Retinal fundus photograph; 848x848; 45° FOV; NIDEK AFC-230; without pupil dilation — 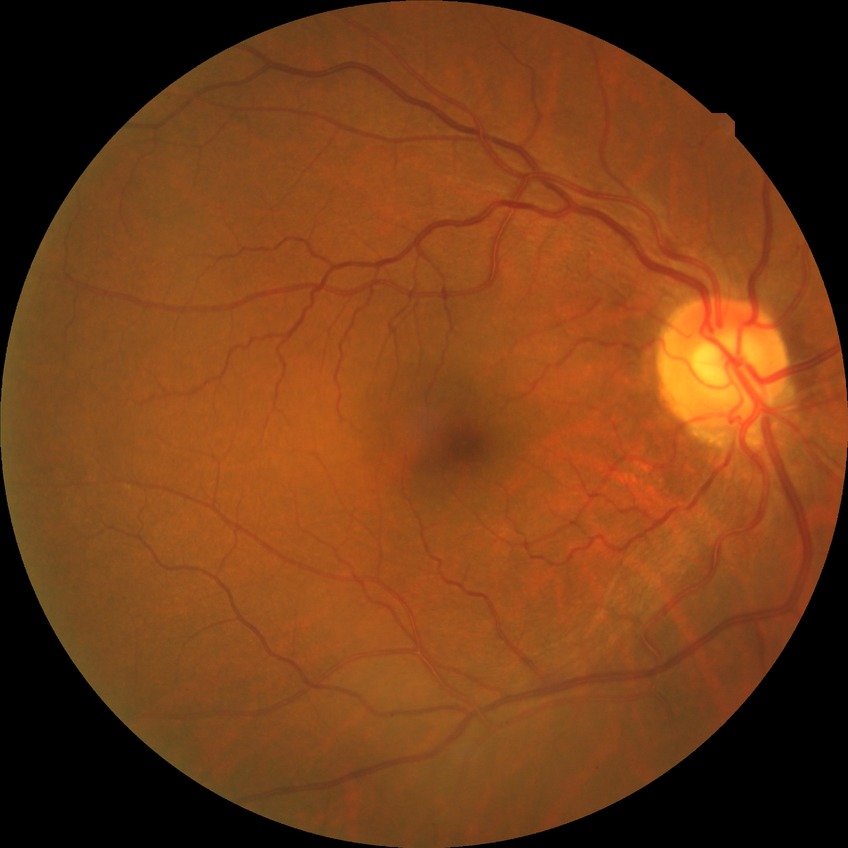
Diabetic retinopathy (DR) is NDR (no diabetic retinopathy).